FOV: 45 degrees. Color fundus image. 2212x1659px.
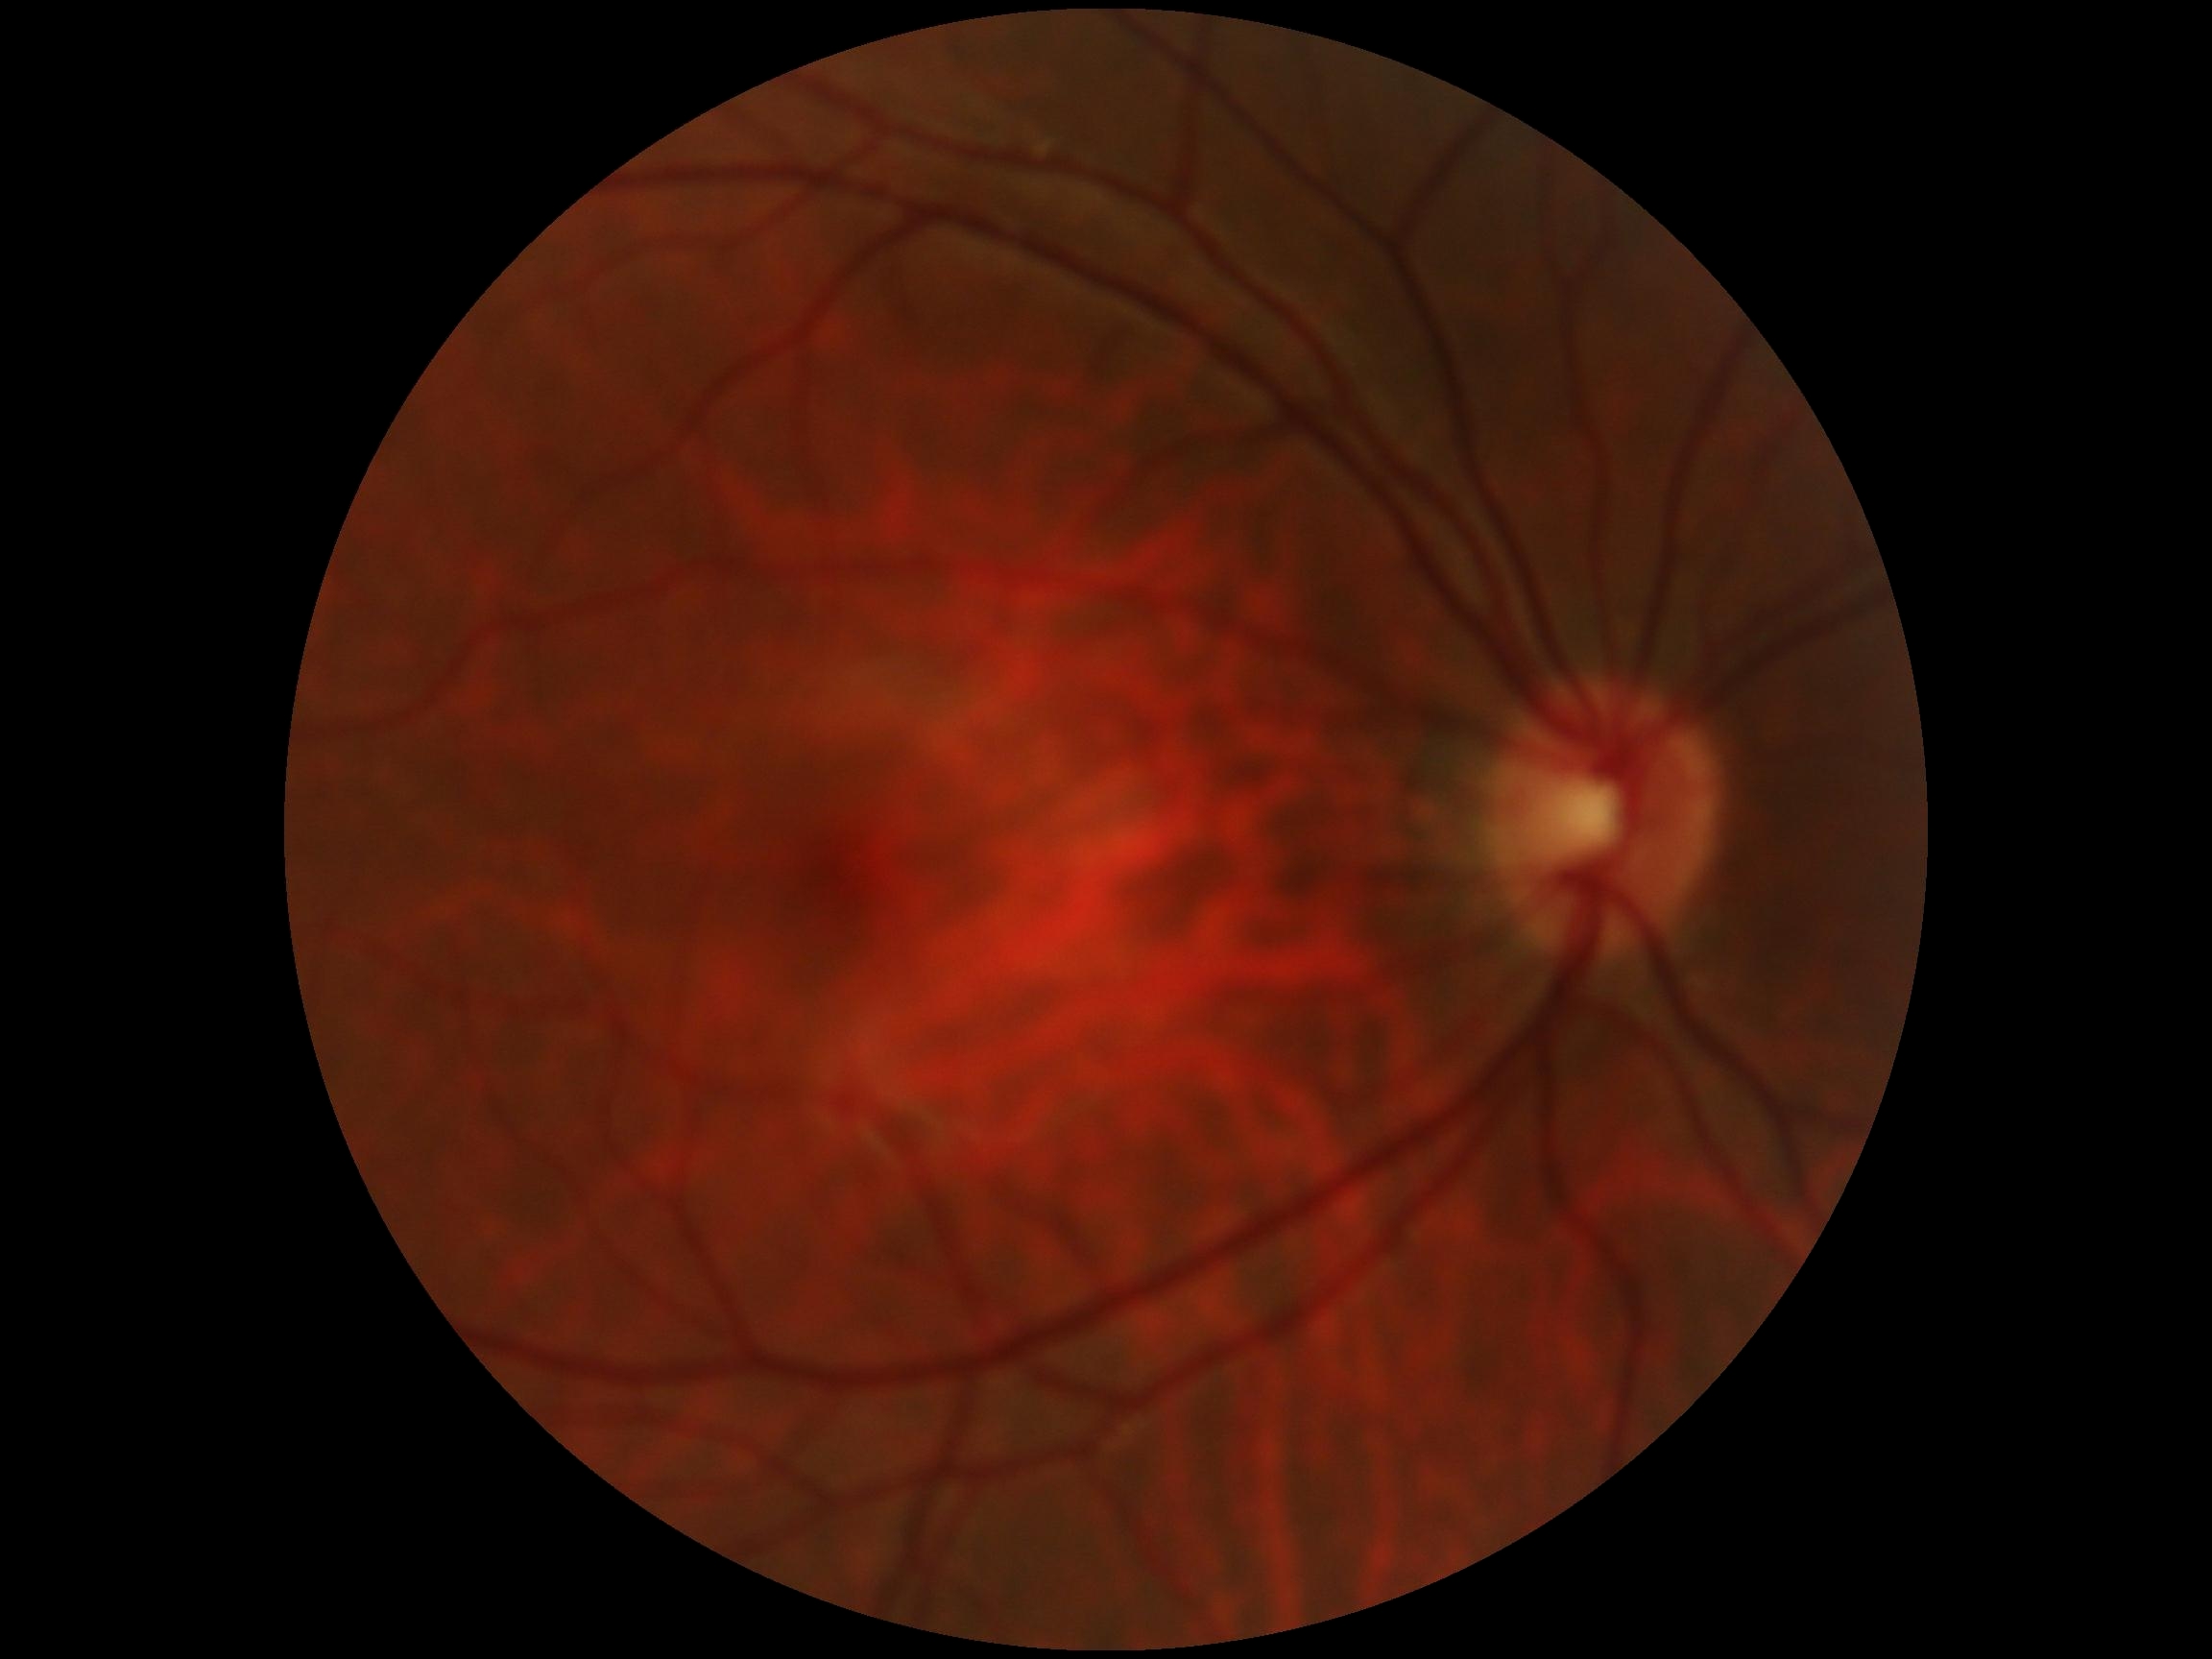

retinopathy grade: 0/4.